Color fundus image:
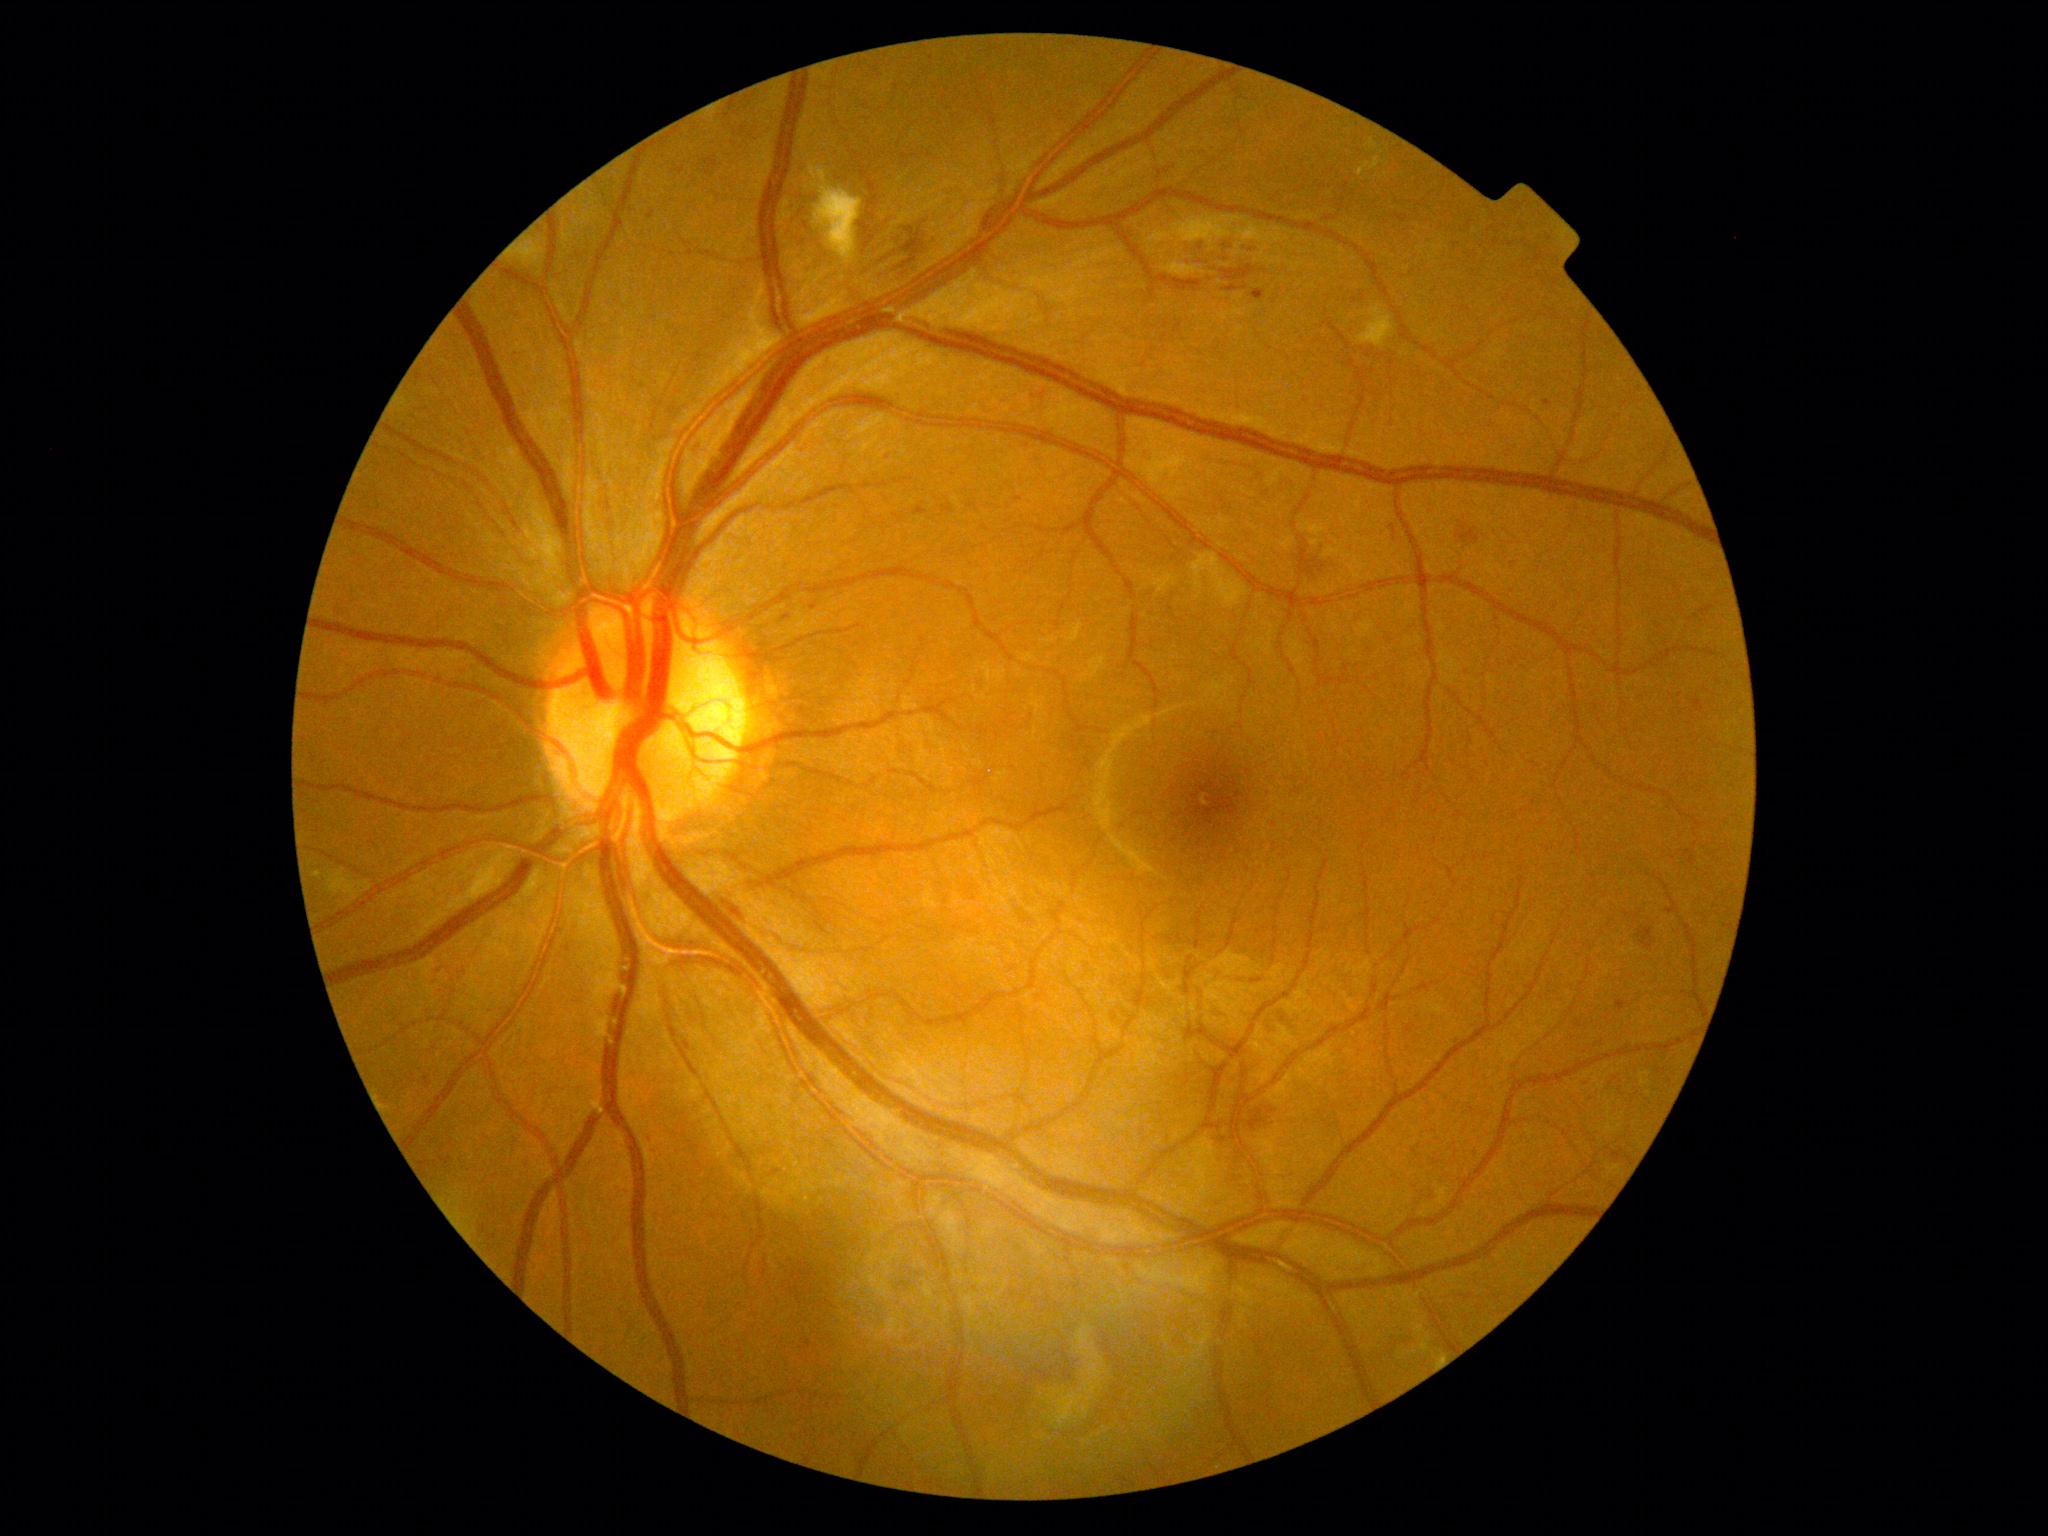 Diabetic retinopathy (DR) is 2/4
Representative lesions:
hemorrhages (HEs) (subset): box(648, 212, 655, 220), box(677, 167, 685, 175), box(914, 506, 928, 517), box(1222, 256, 1237, 265), box(1156, 270, 1206, 293), box(860, 222, 875, 255), box(1456, 529, 1480, 544), box(705, 159, 718, 176), box(1189, 252, 1217, 266), box(1266, 1107, 1277, 1114), box(724, 897, 747, 923), box(684, 1041, 695, 1056)